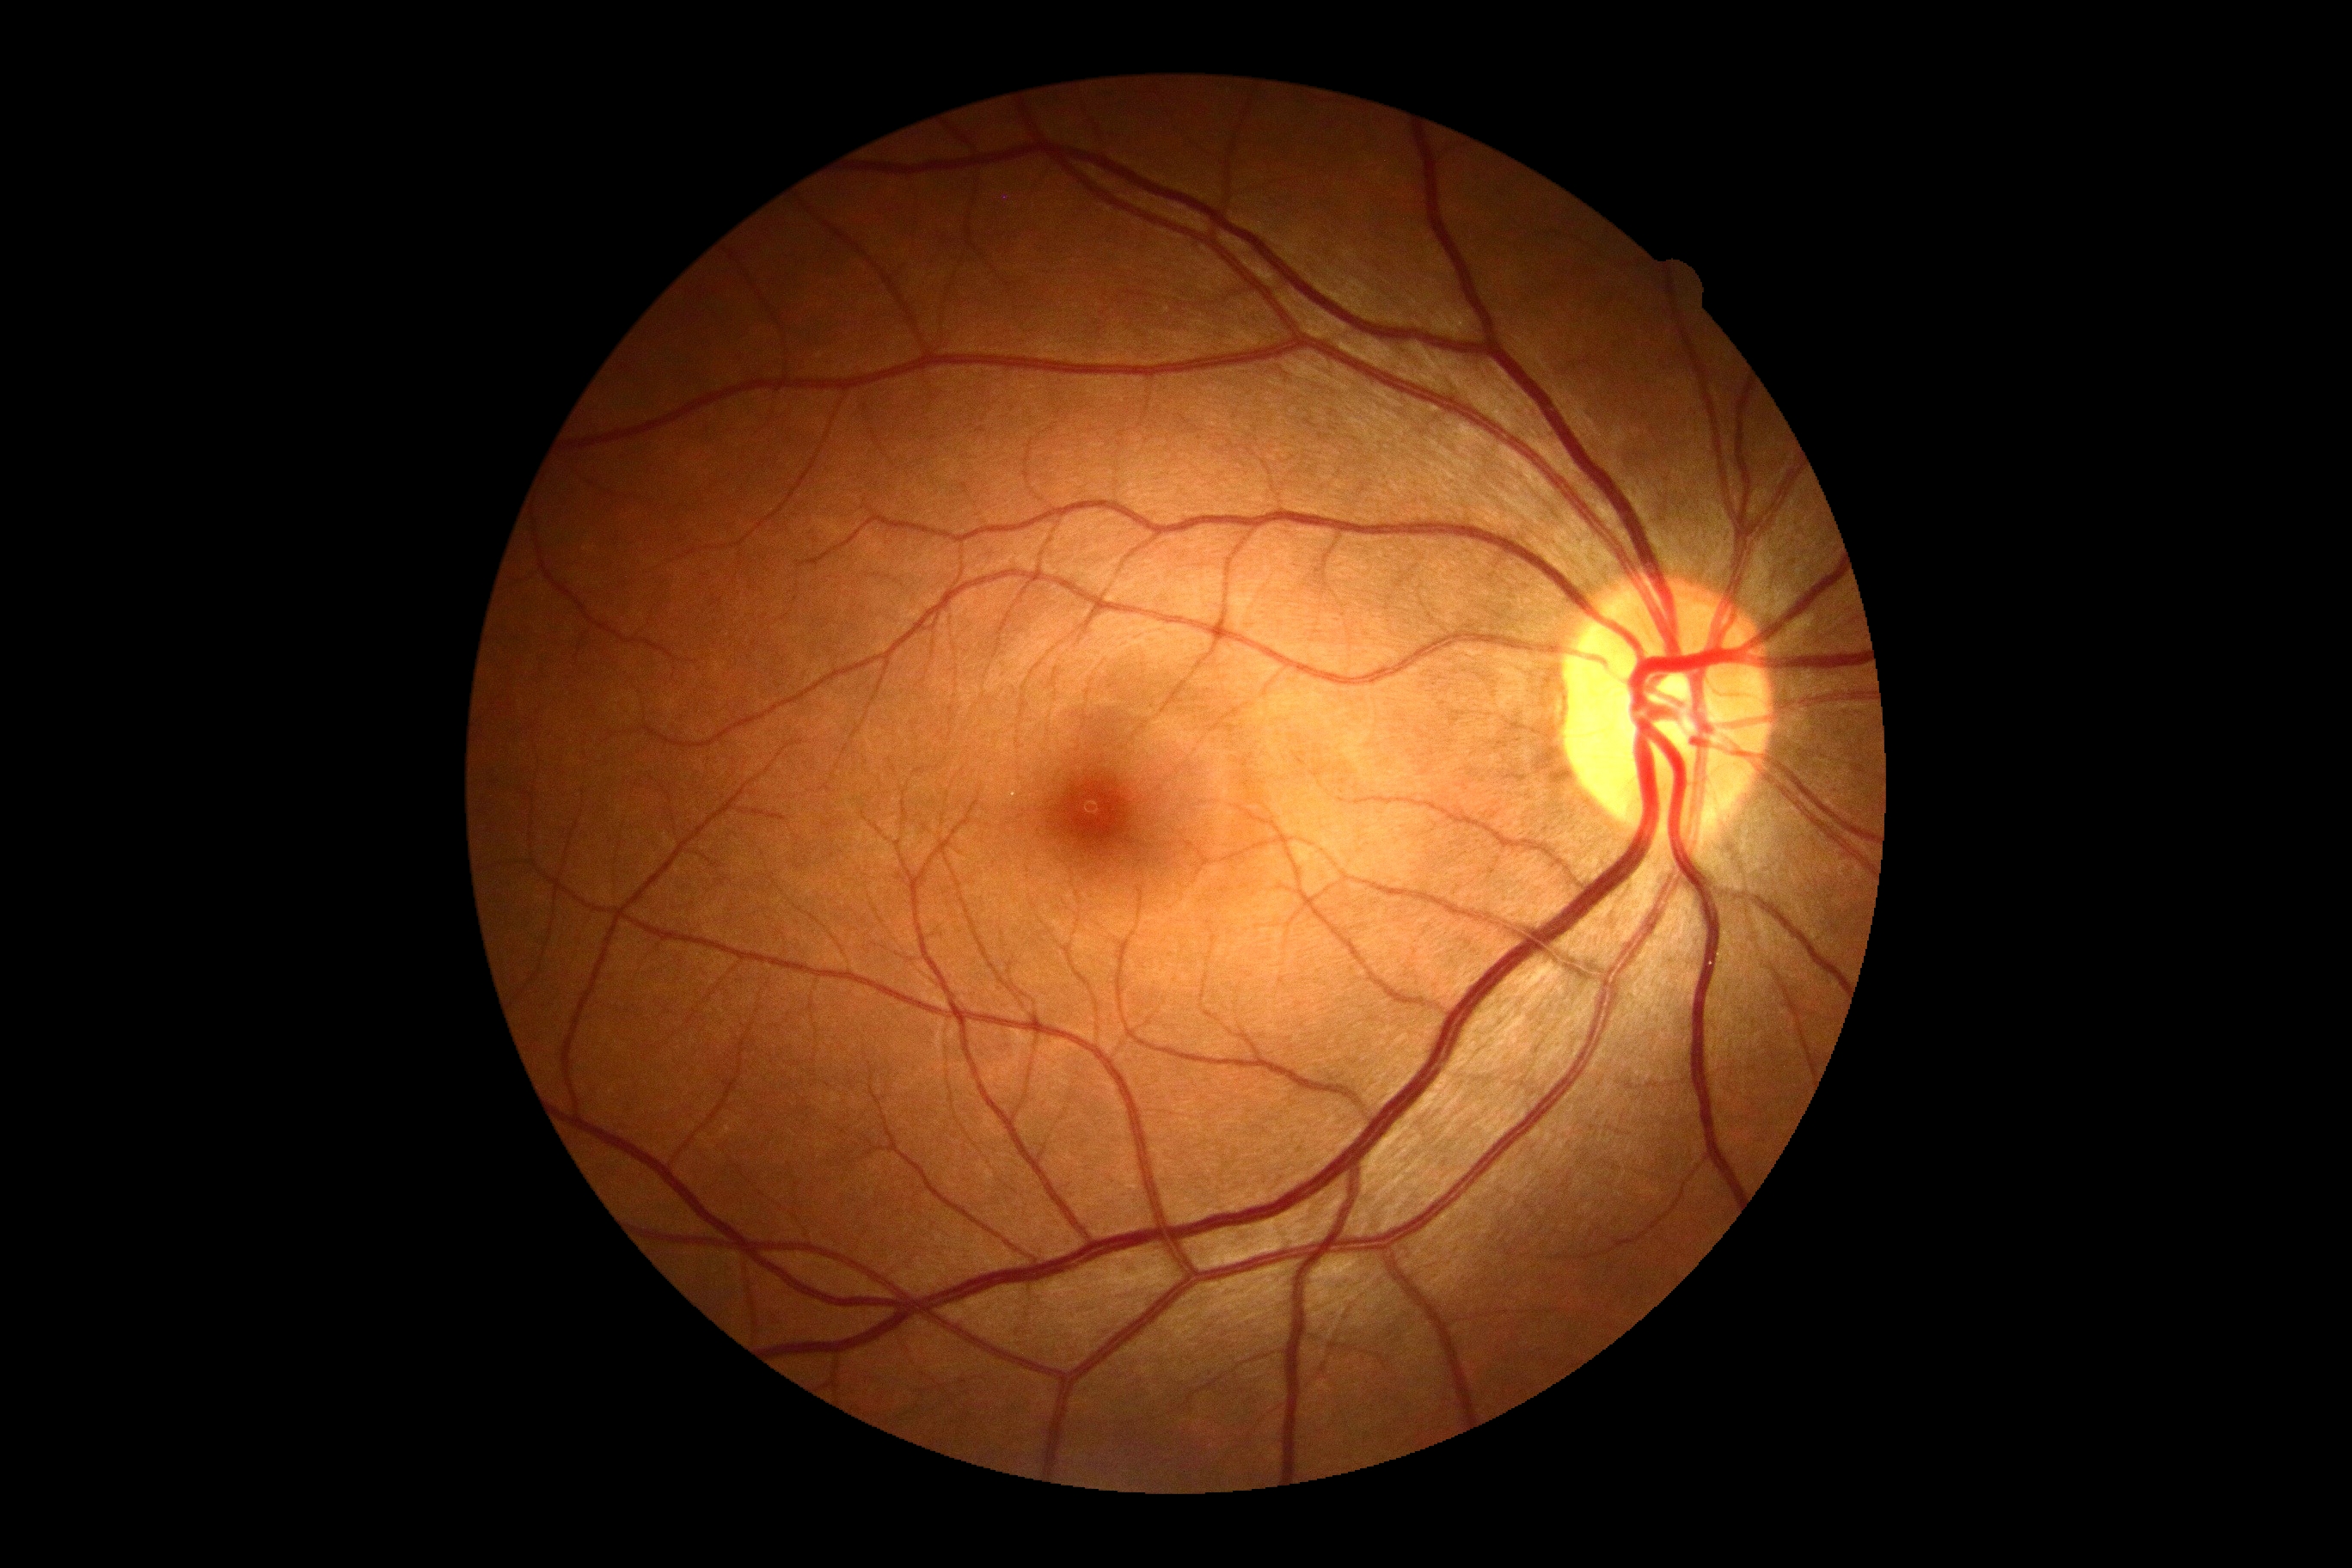 Diabetic retinopathy (DR): no apparent diabetic retinopathy (grade 0).